45-degree field of view — 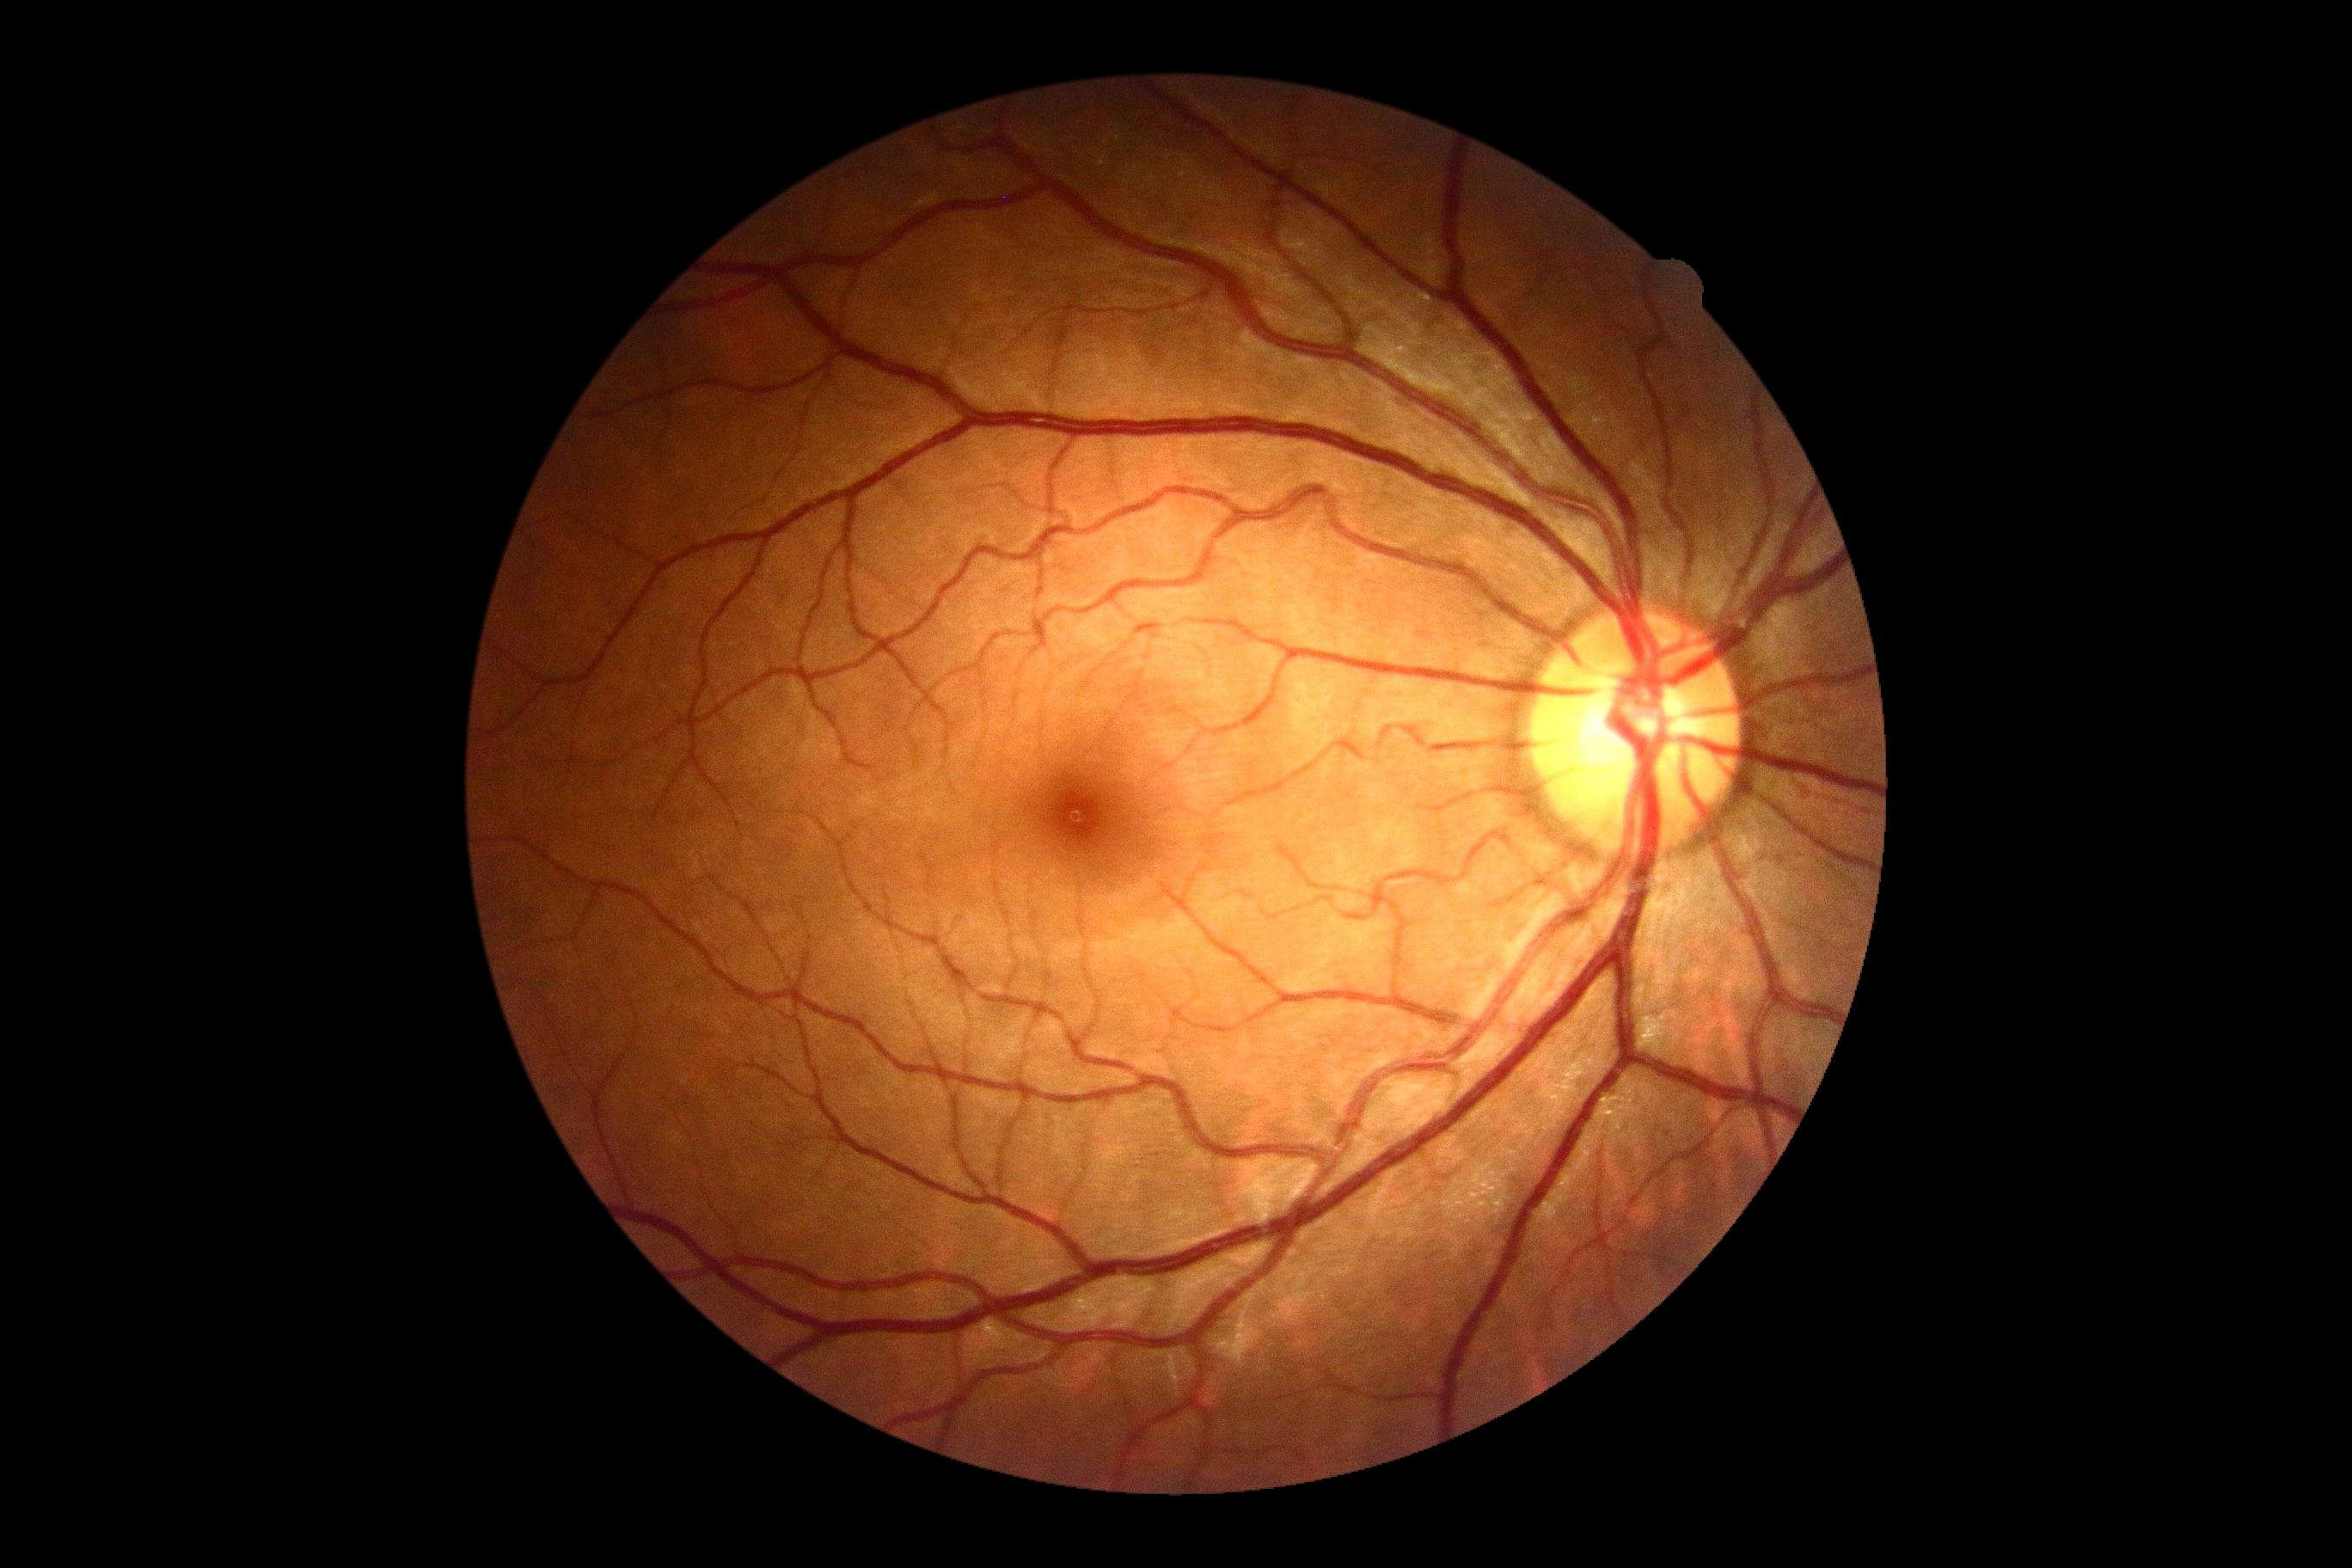
DR: grade 0 (no apparent retinopathy).
No DR findings.